45° field of view, 2352x1568px, retinal fundus photograph.
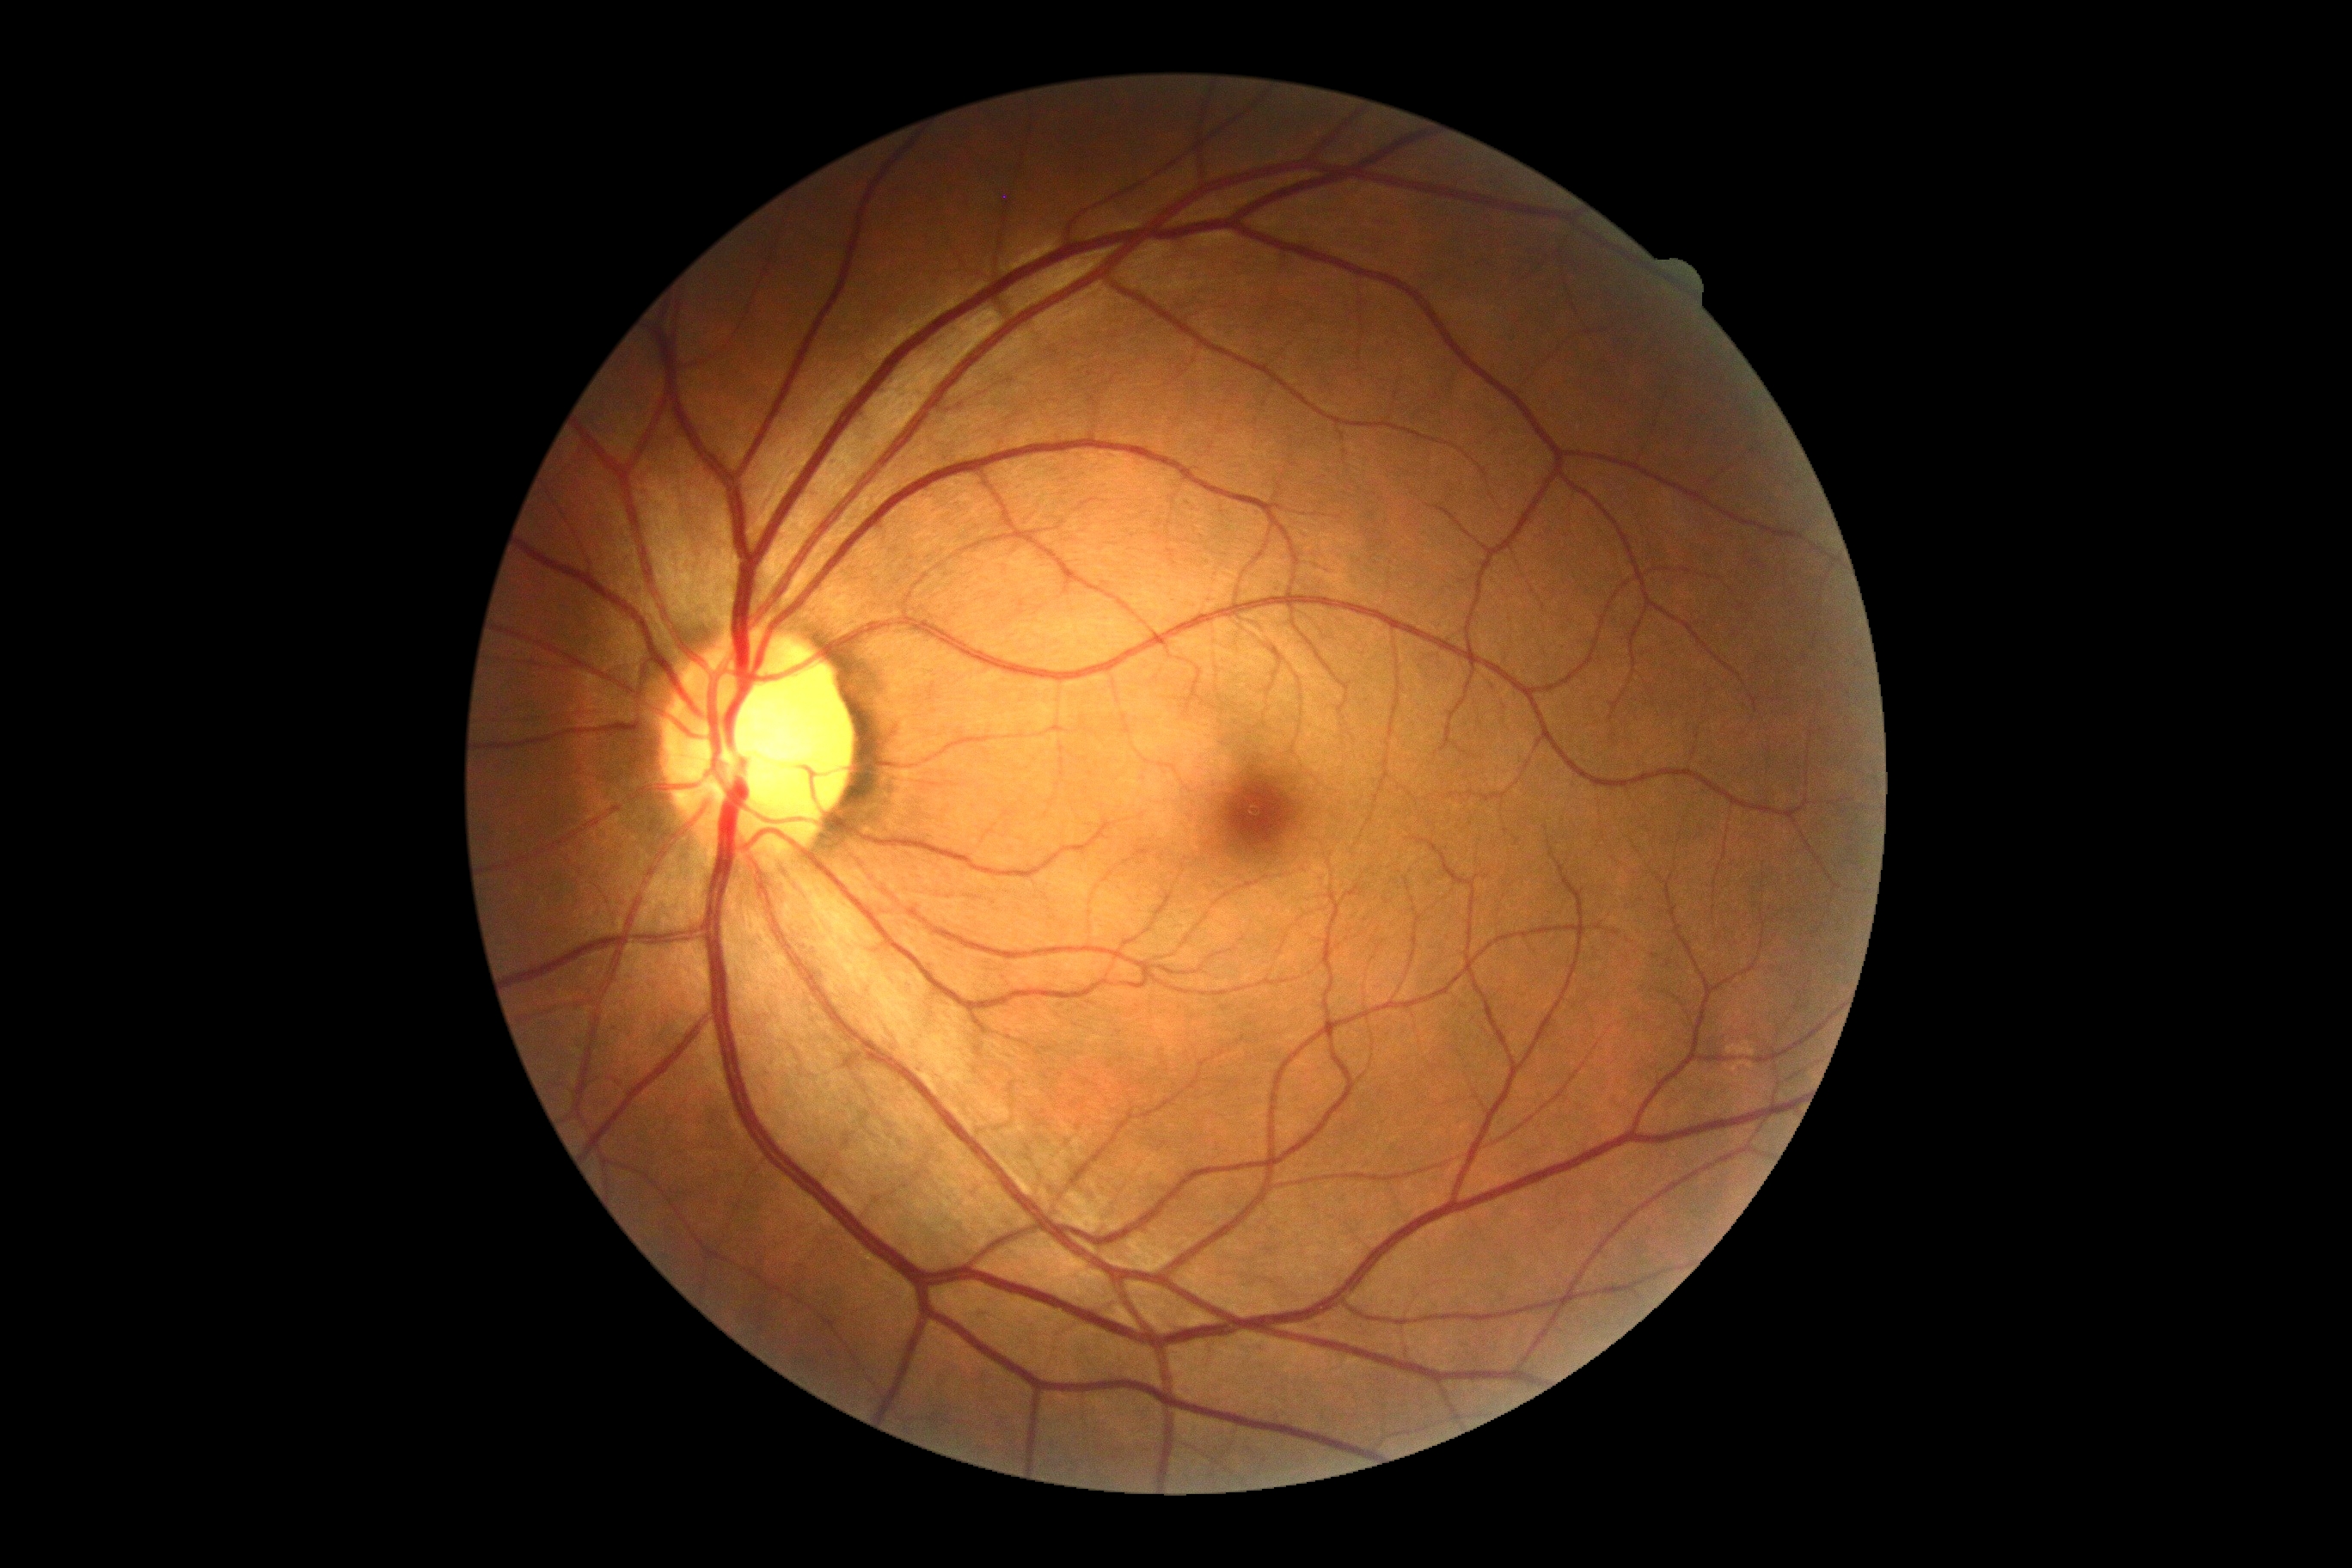 diabetic retinopathy (DR)=0/4.